Image size 2352x1568.
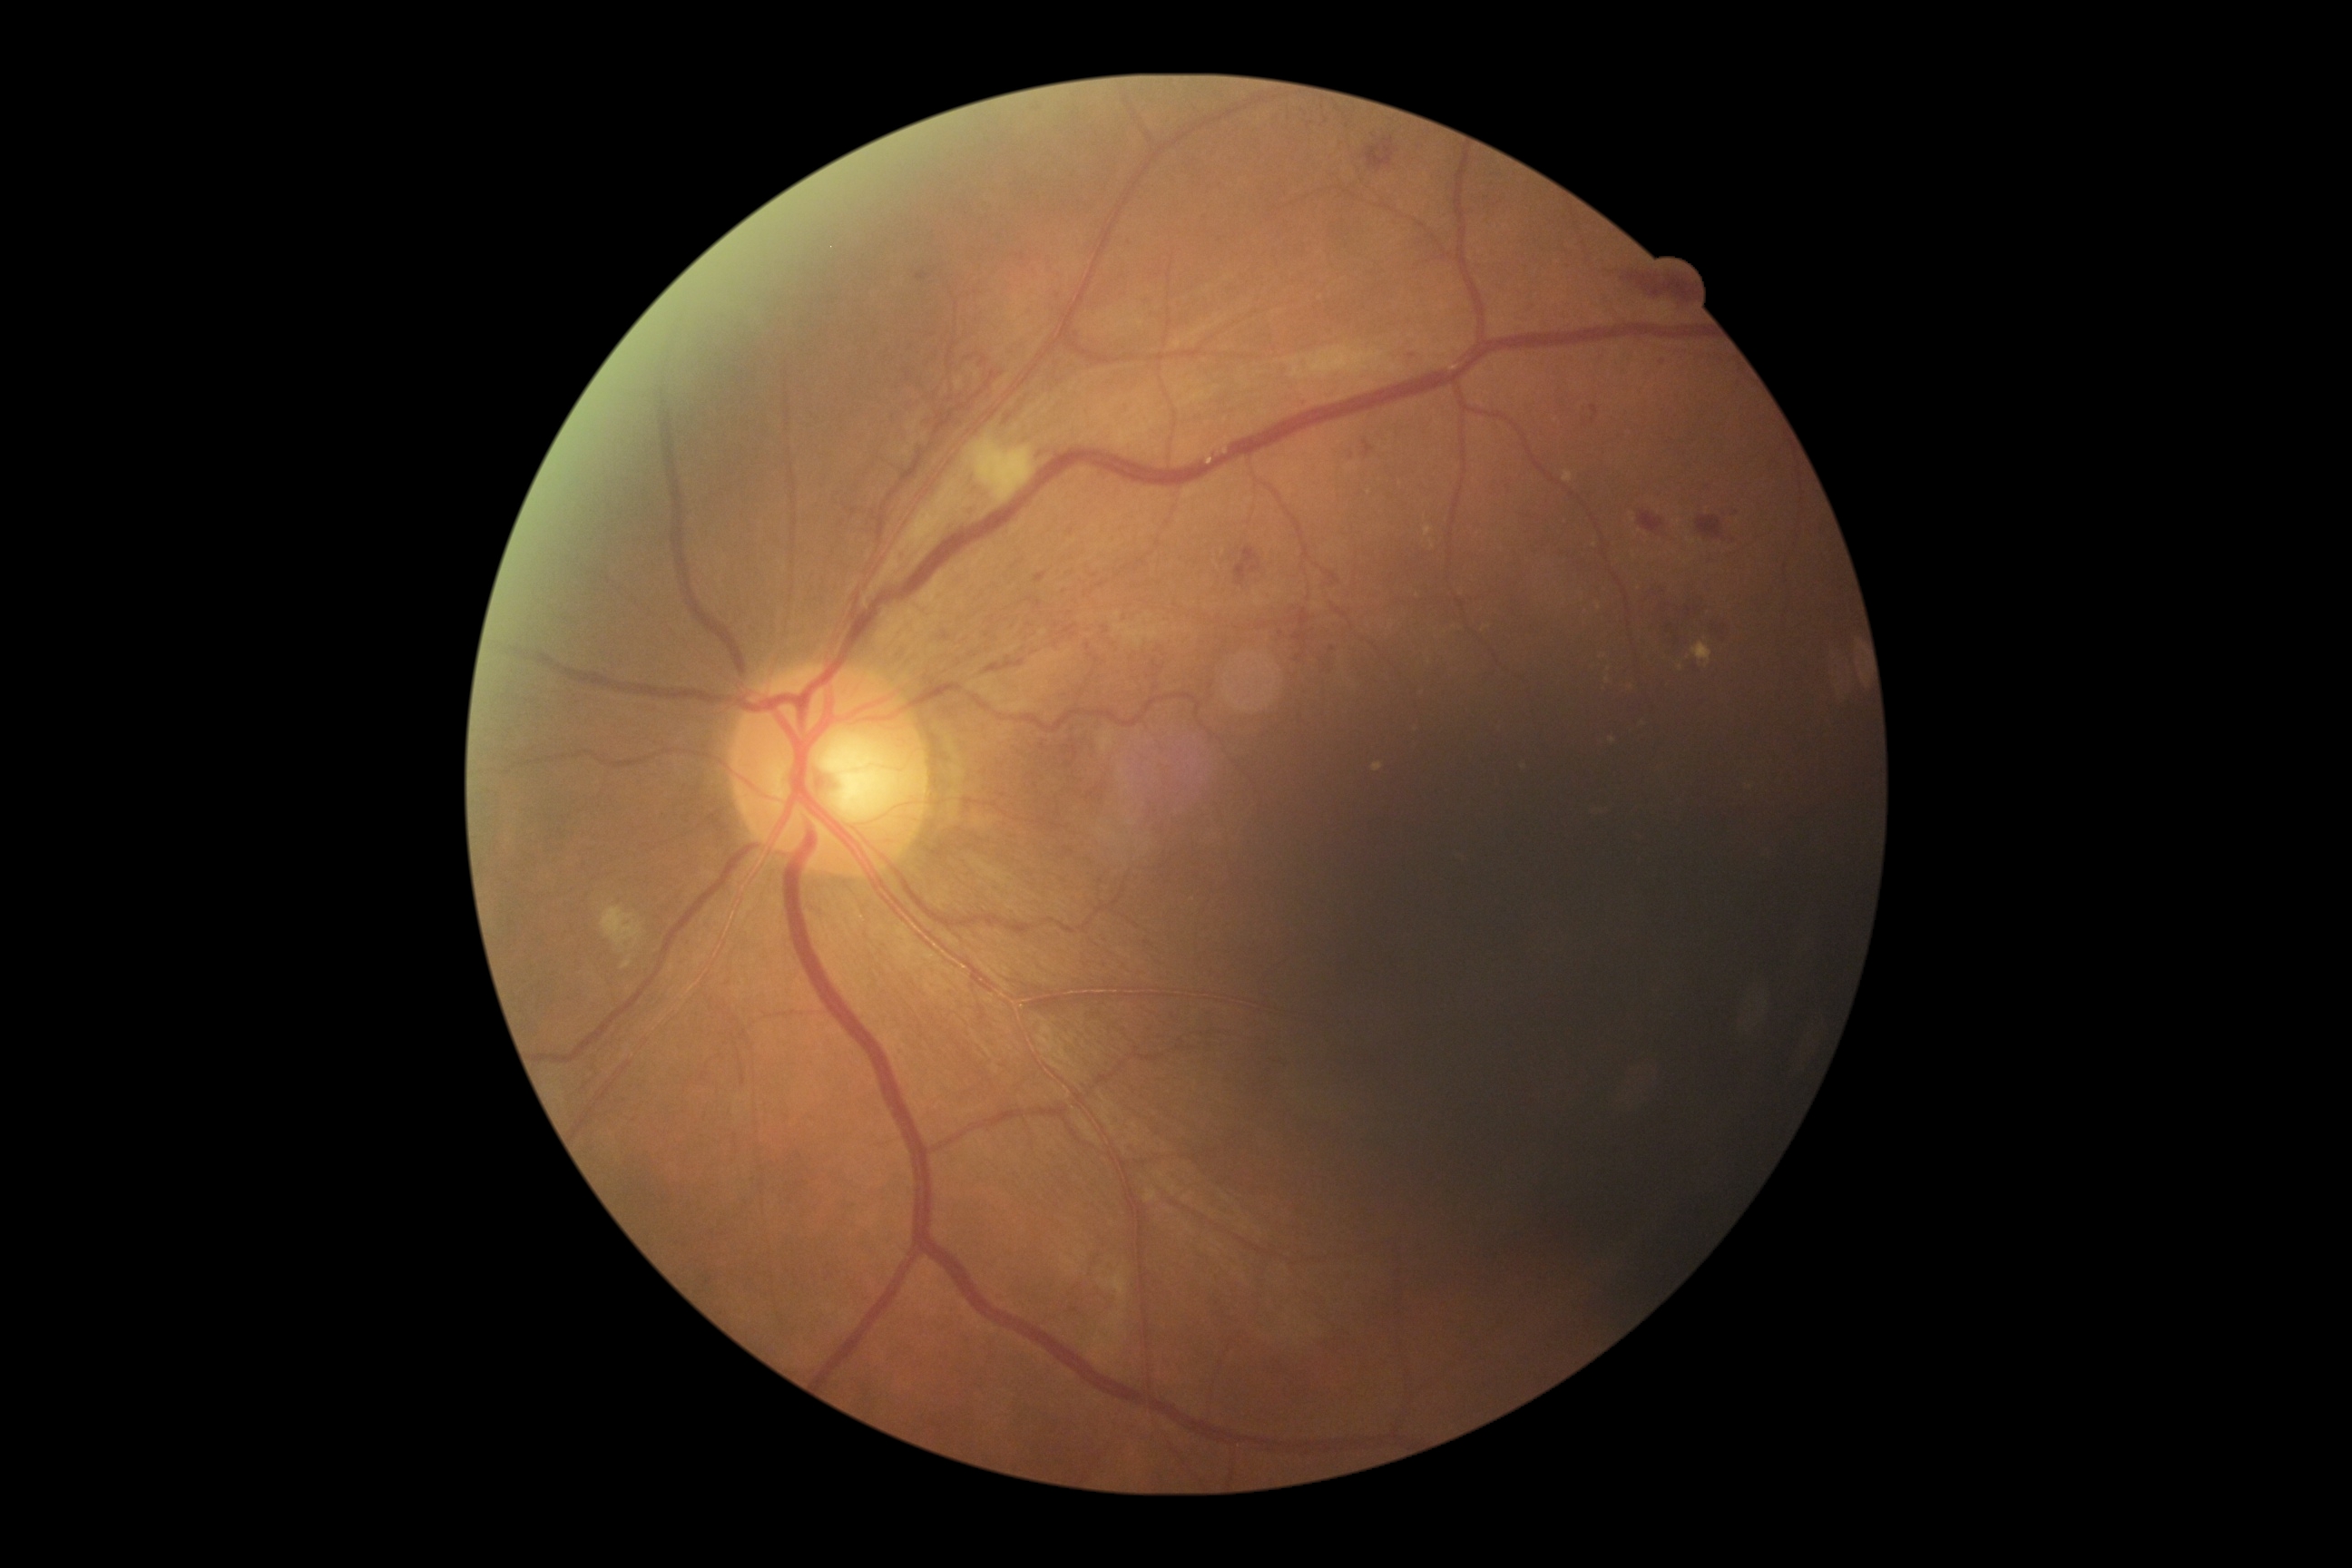

diabetic retinopathy grade = severe non-proliferative diabetic retinopathy (3) — more than 20 intraretinal hemorrhages in each of 4 quadrants, definite venous beading in 2 or more quadrants, or prominent intraretinal microvascular abnormalities in 1 or more quadrants, with no signs of proliferative retinopathy.